Color fundus photograph: 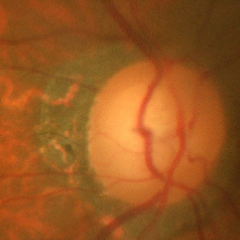 Glaucoma assessment = severe glaucomatous damage. Diagnostic criteria: near-total cupping of the optic nerve head, with or without severe visual field loss within the central 10 degrees of fixation.